130° field of view (Natus RetCam Envision) · wide-field fundus photograph of an infant — 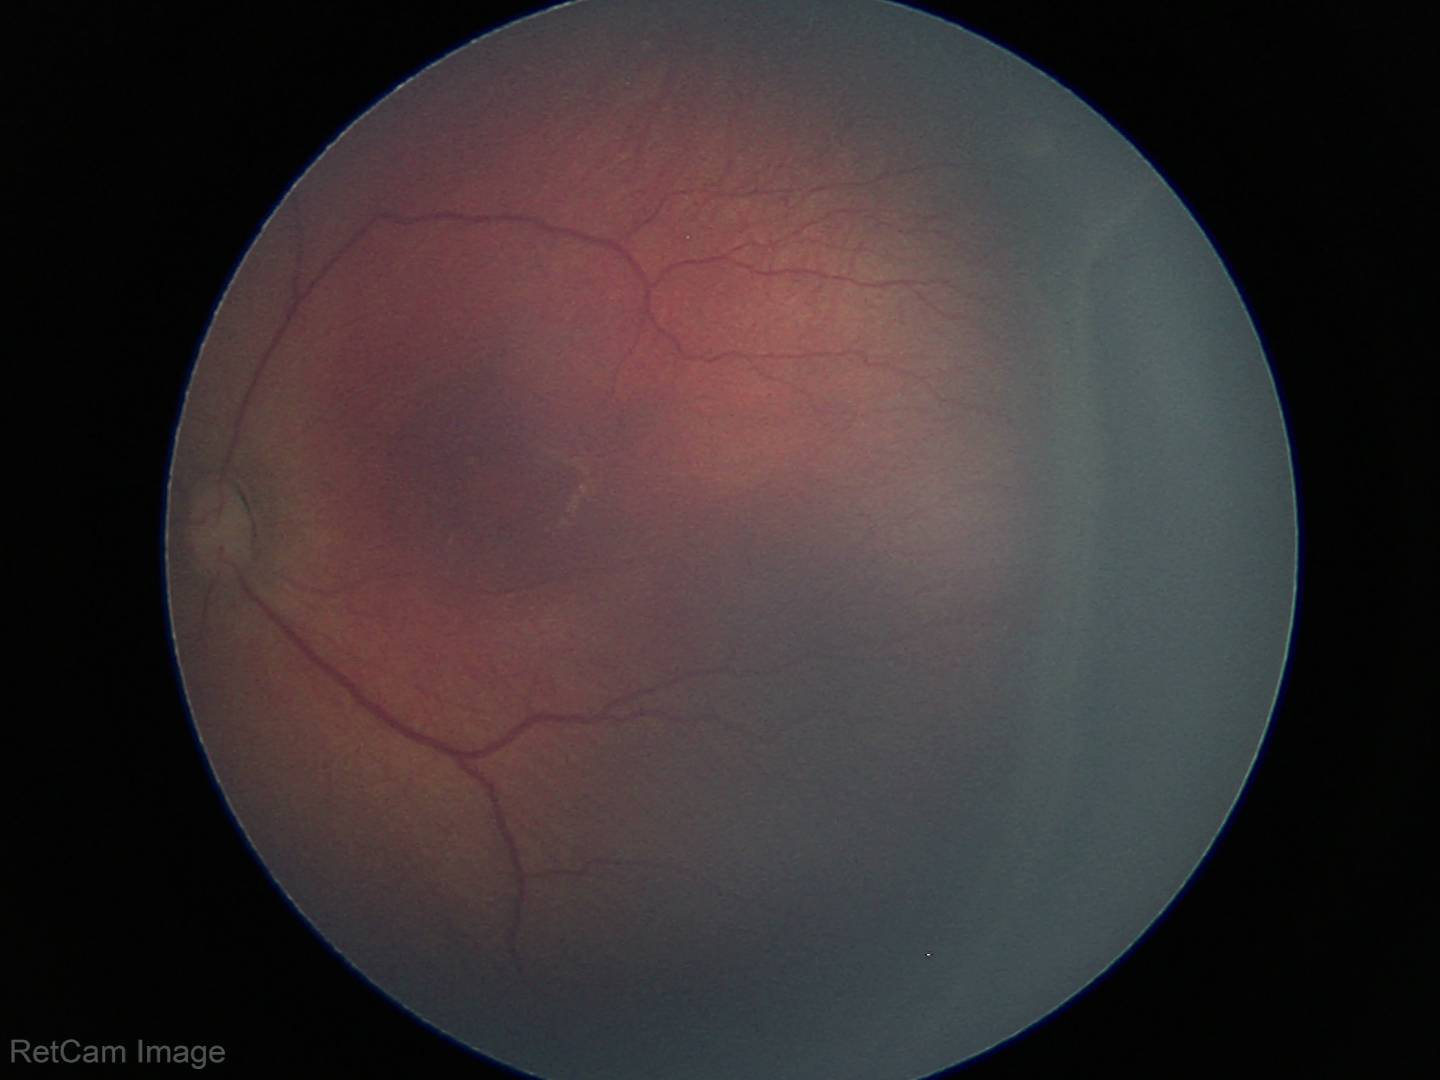
No plus disease.
Series diagnosed as retinopathy of prematurity (ROP) stage 3 — ridge with extraretinal fibrovascular proliferation.